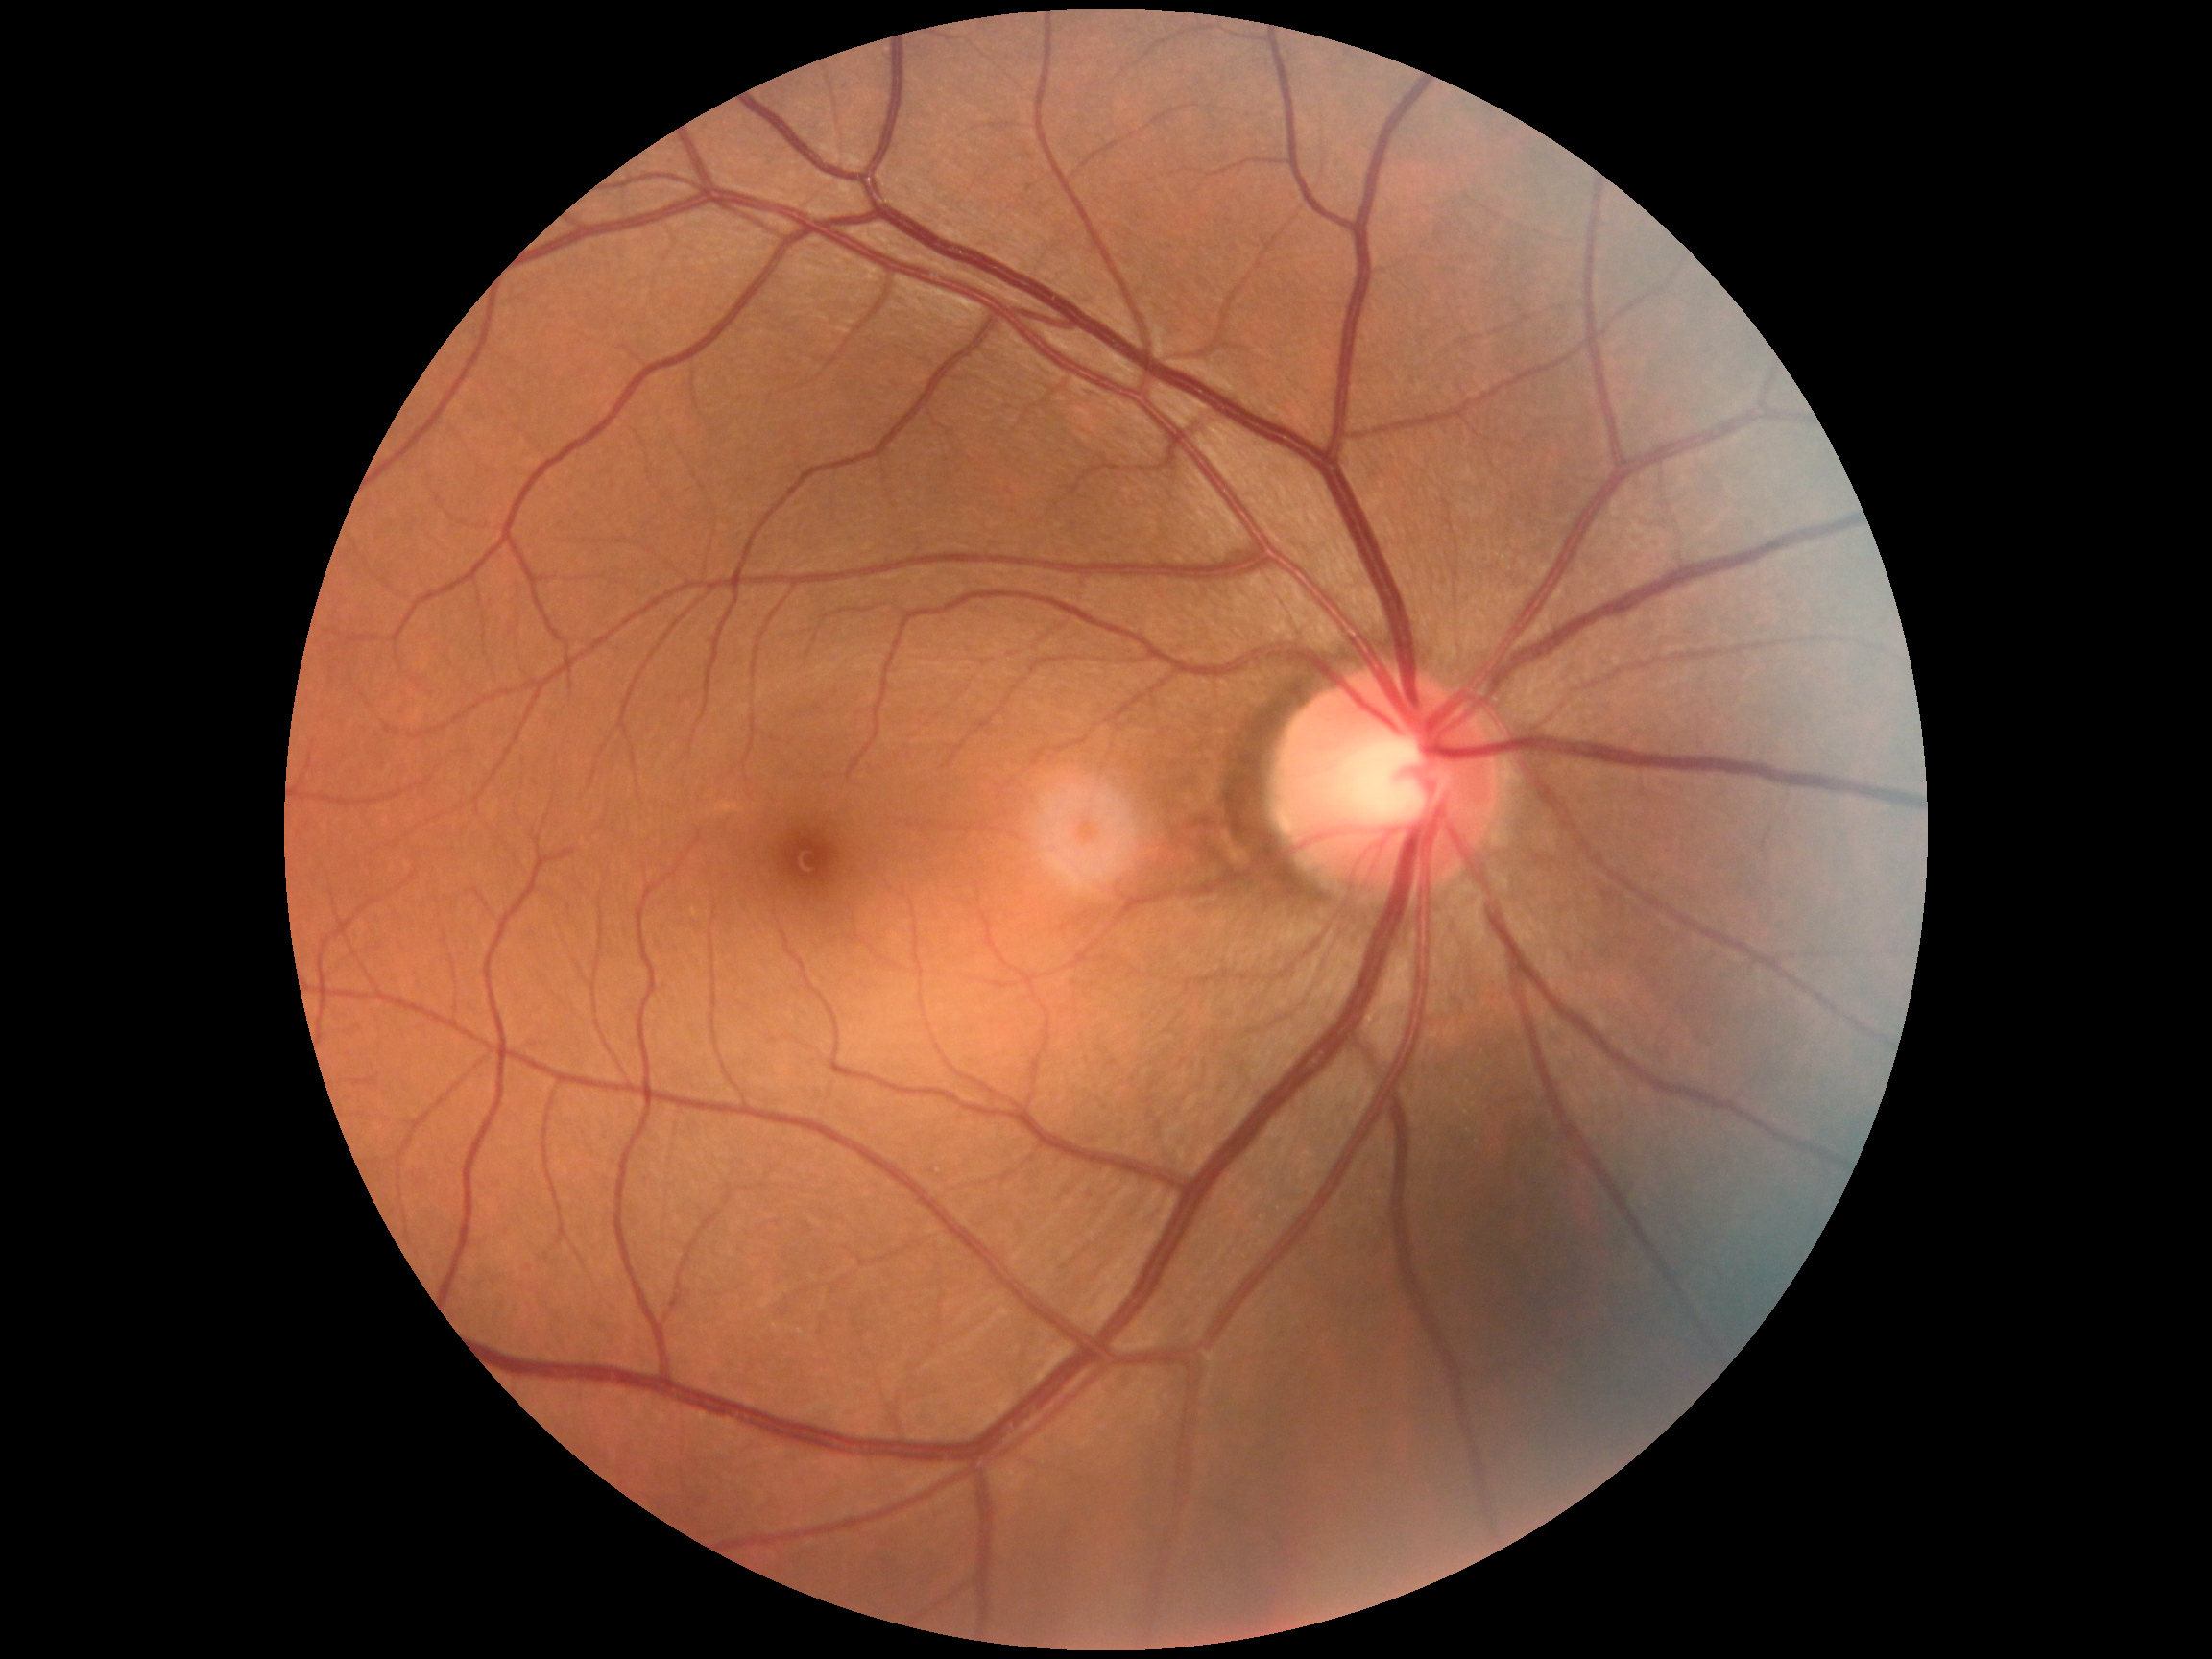

Diabetic retinopathy: 0.